2184x1682, 45° FOV: 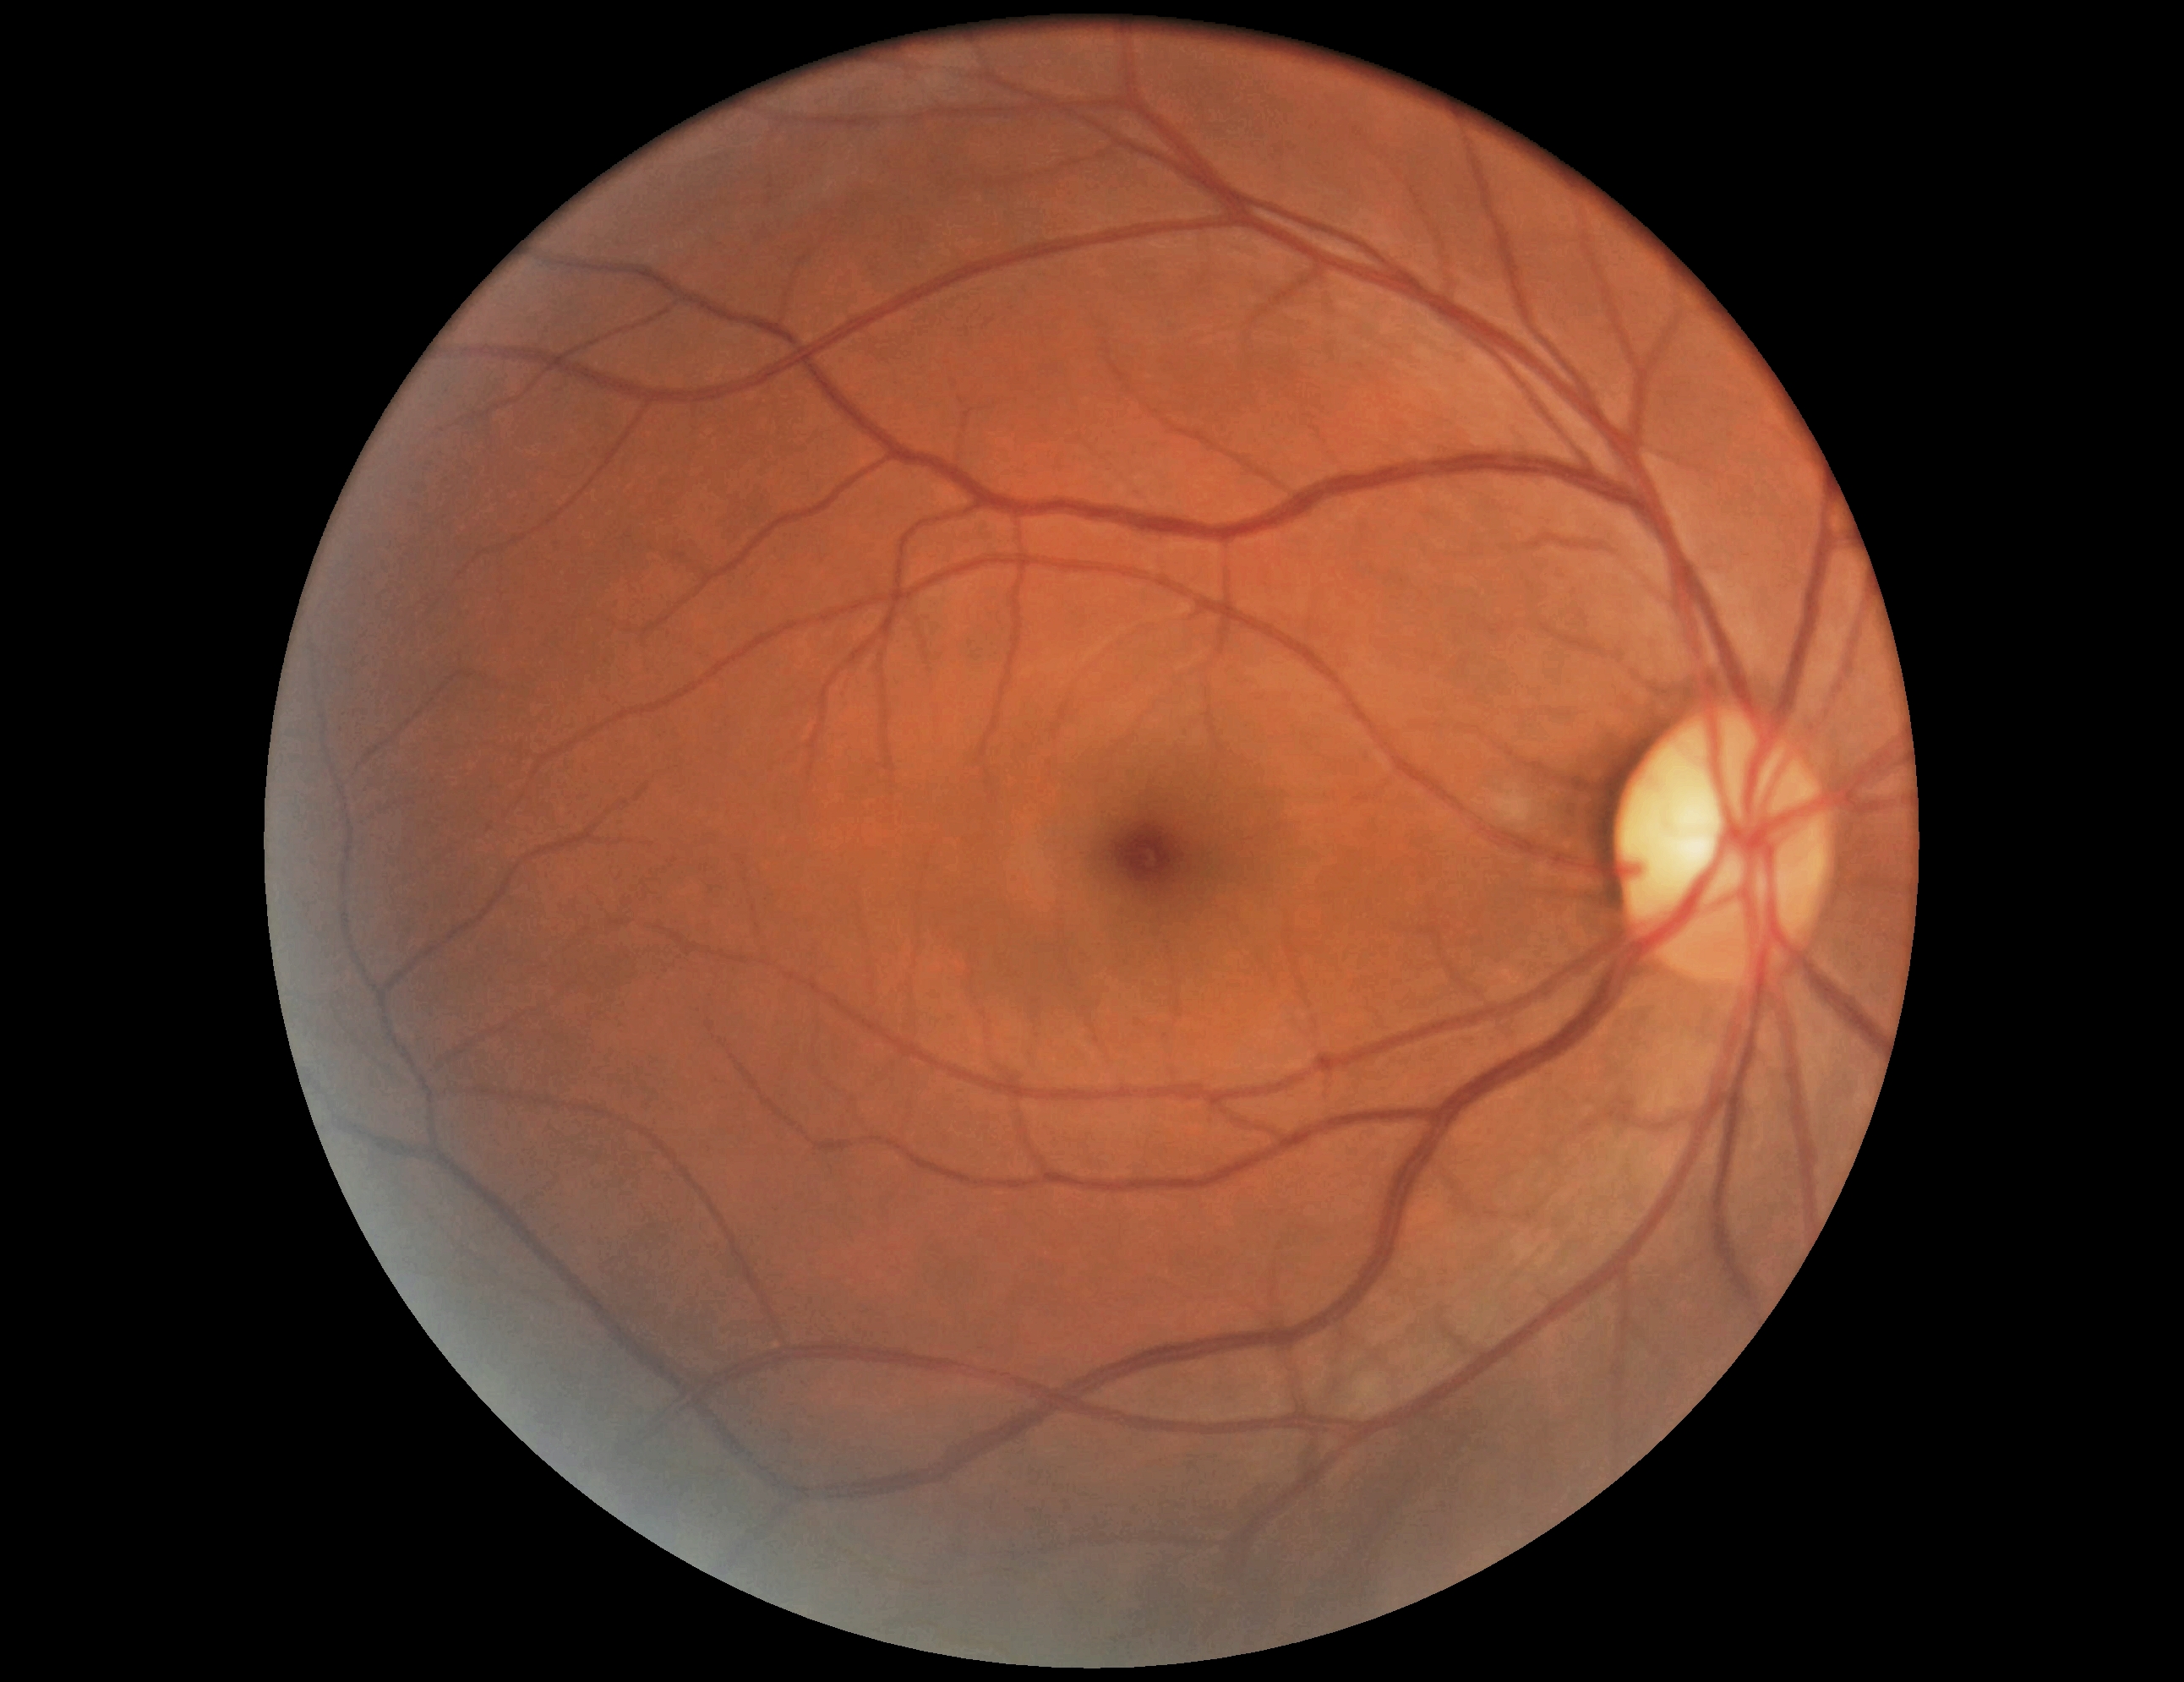
diabetic retinopathy grade: no apparent retinopathy (0); DR impression: no DR findings.